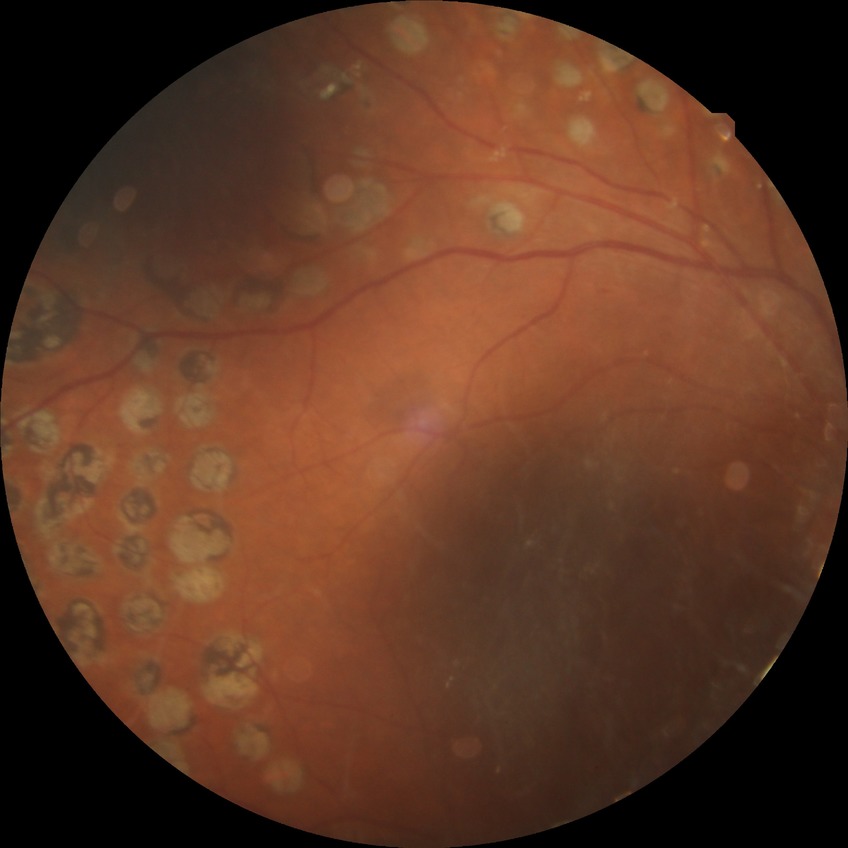

Diabetic retinopathy (DR): proliferative diabetic retinopathy (PDR).